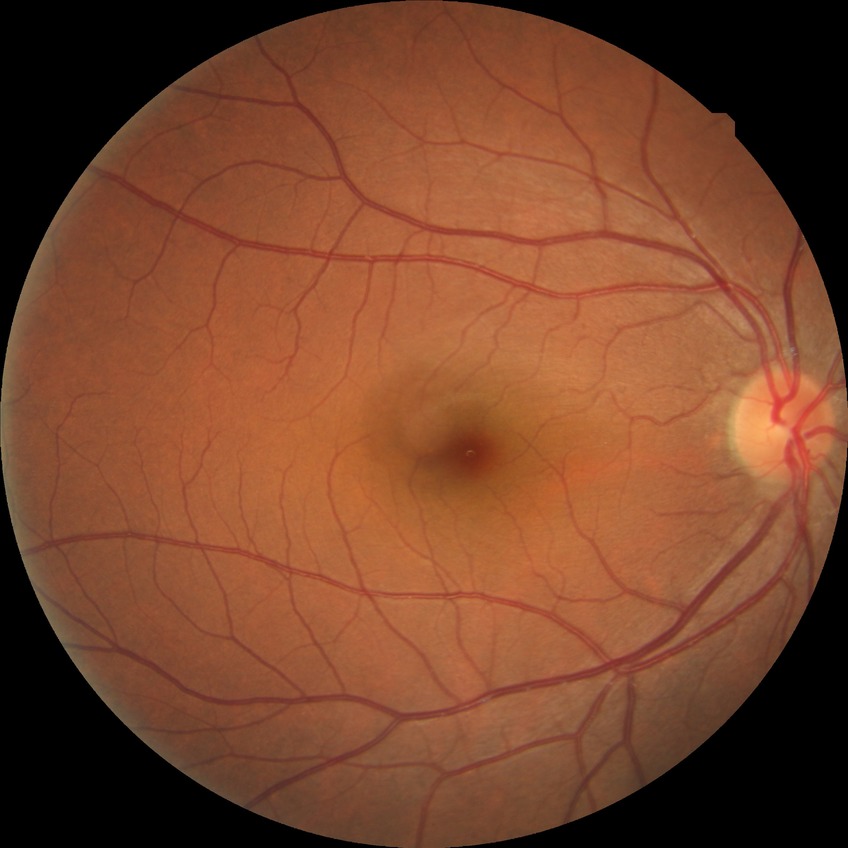

DR severity@NDR.